CFP · modified Davis grading · image size 848x848.
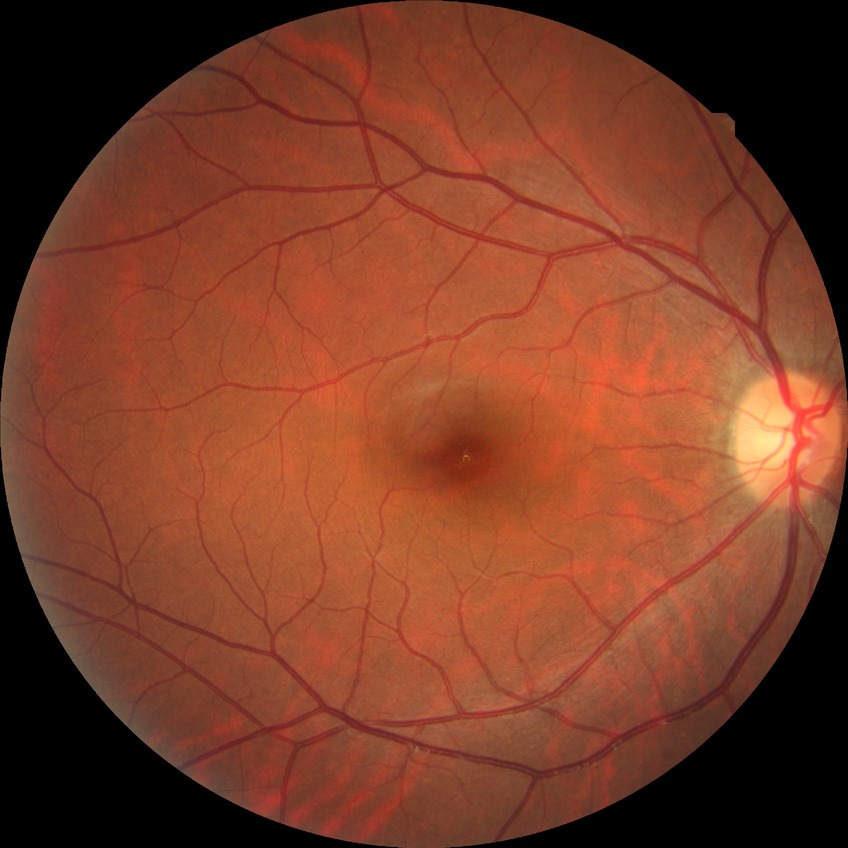

diabetic retinopathy (DR) = NDR (no diabetic retinopathy)